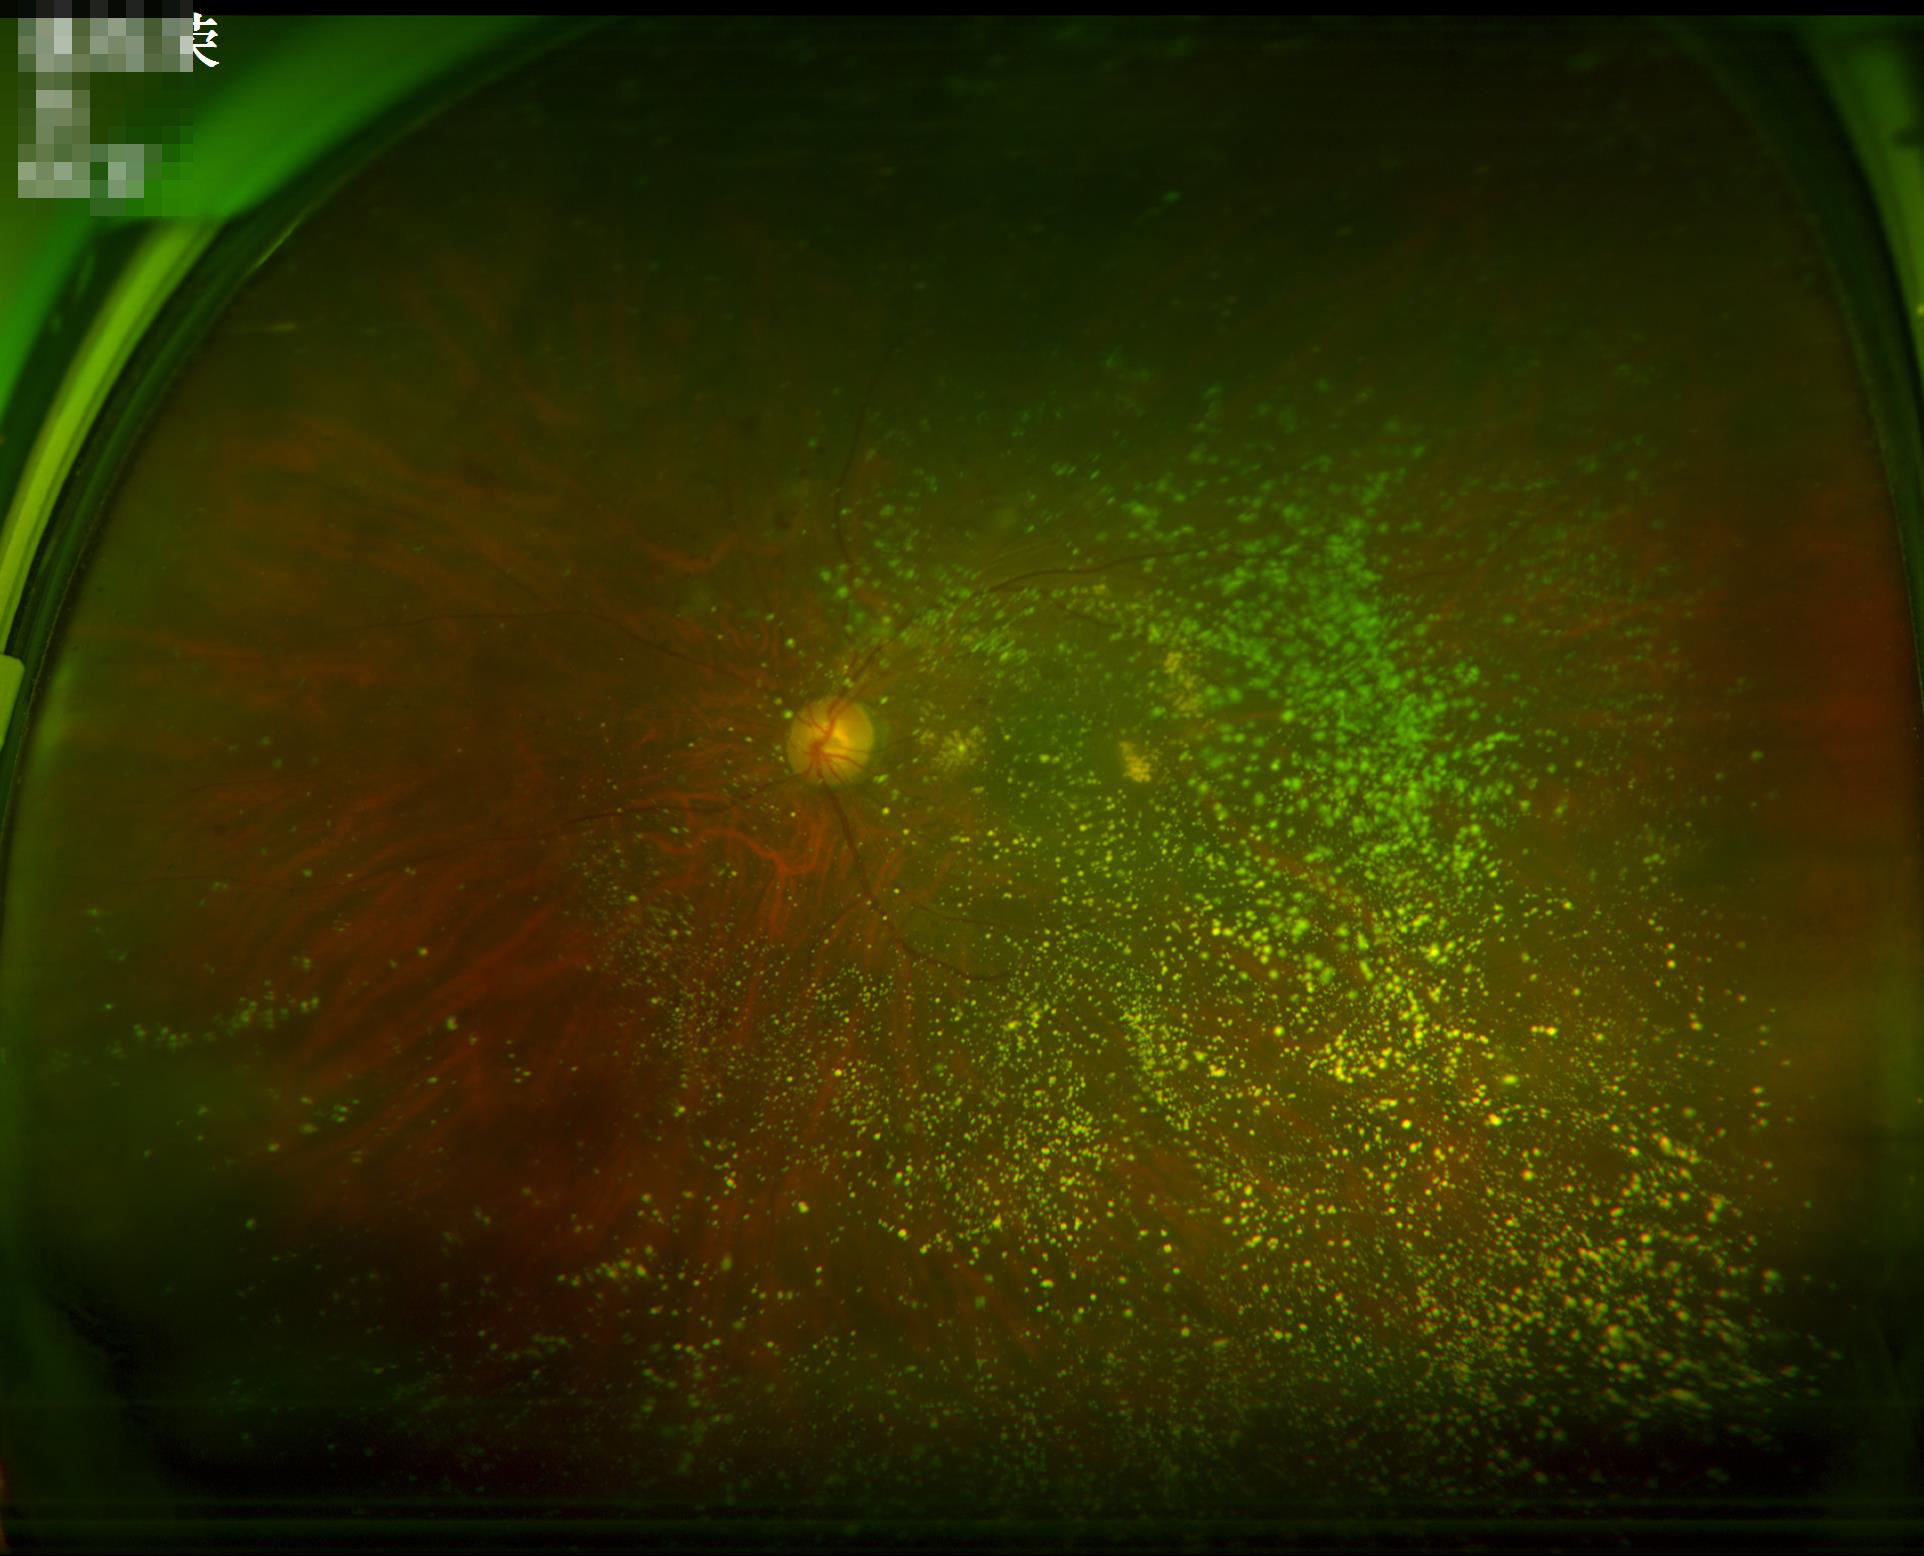

Contrast: low | Clarity: out of focus | Overall quality: poor | Illumination/color: suboptimal.